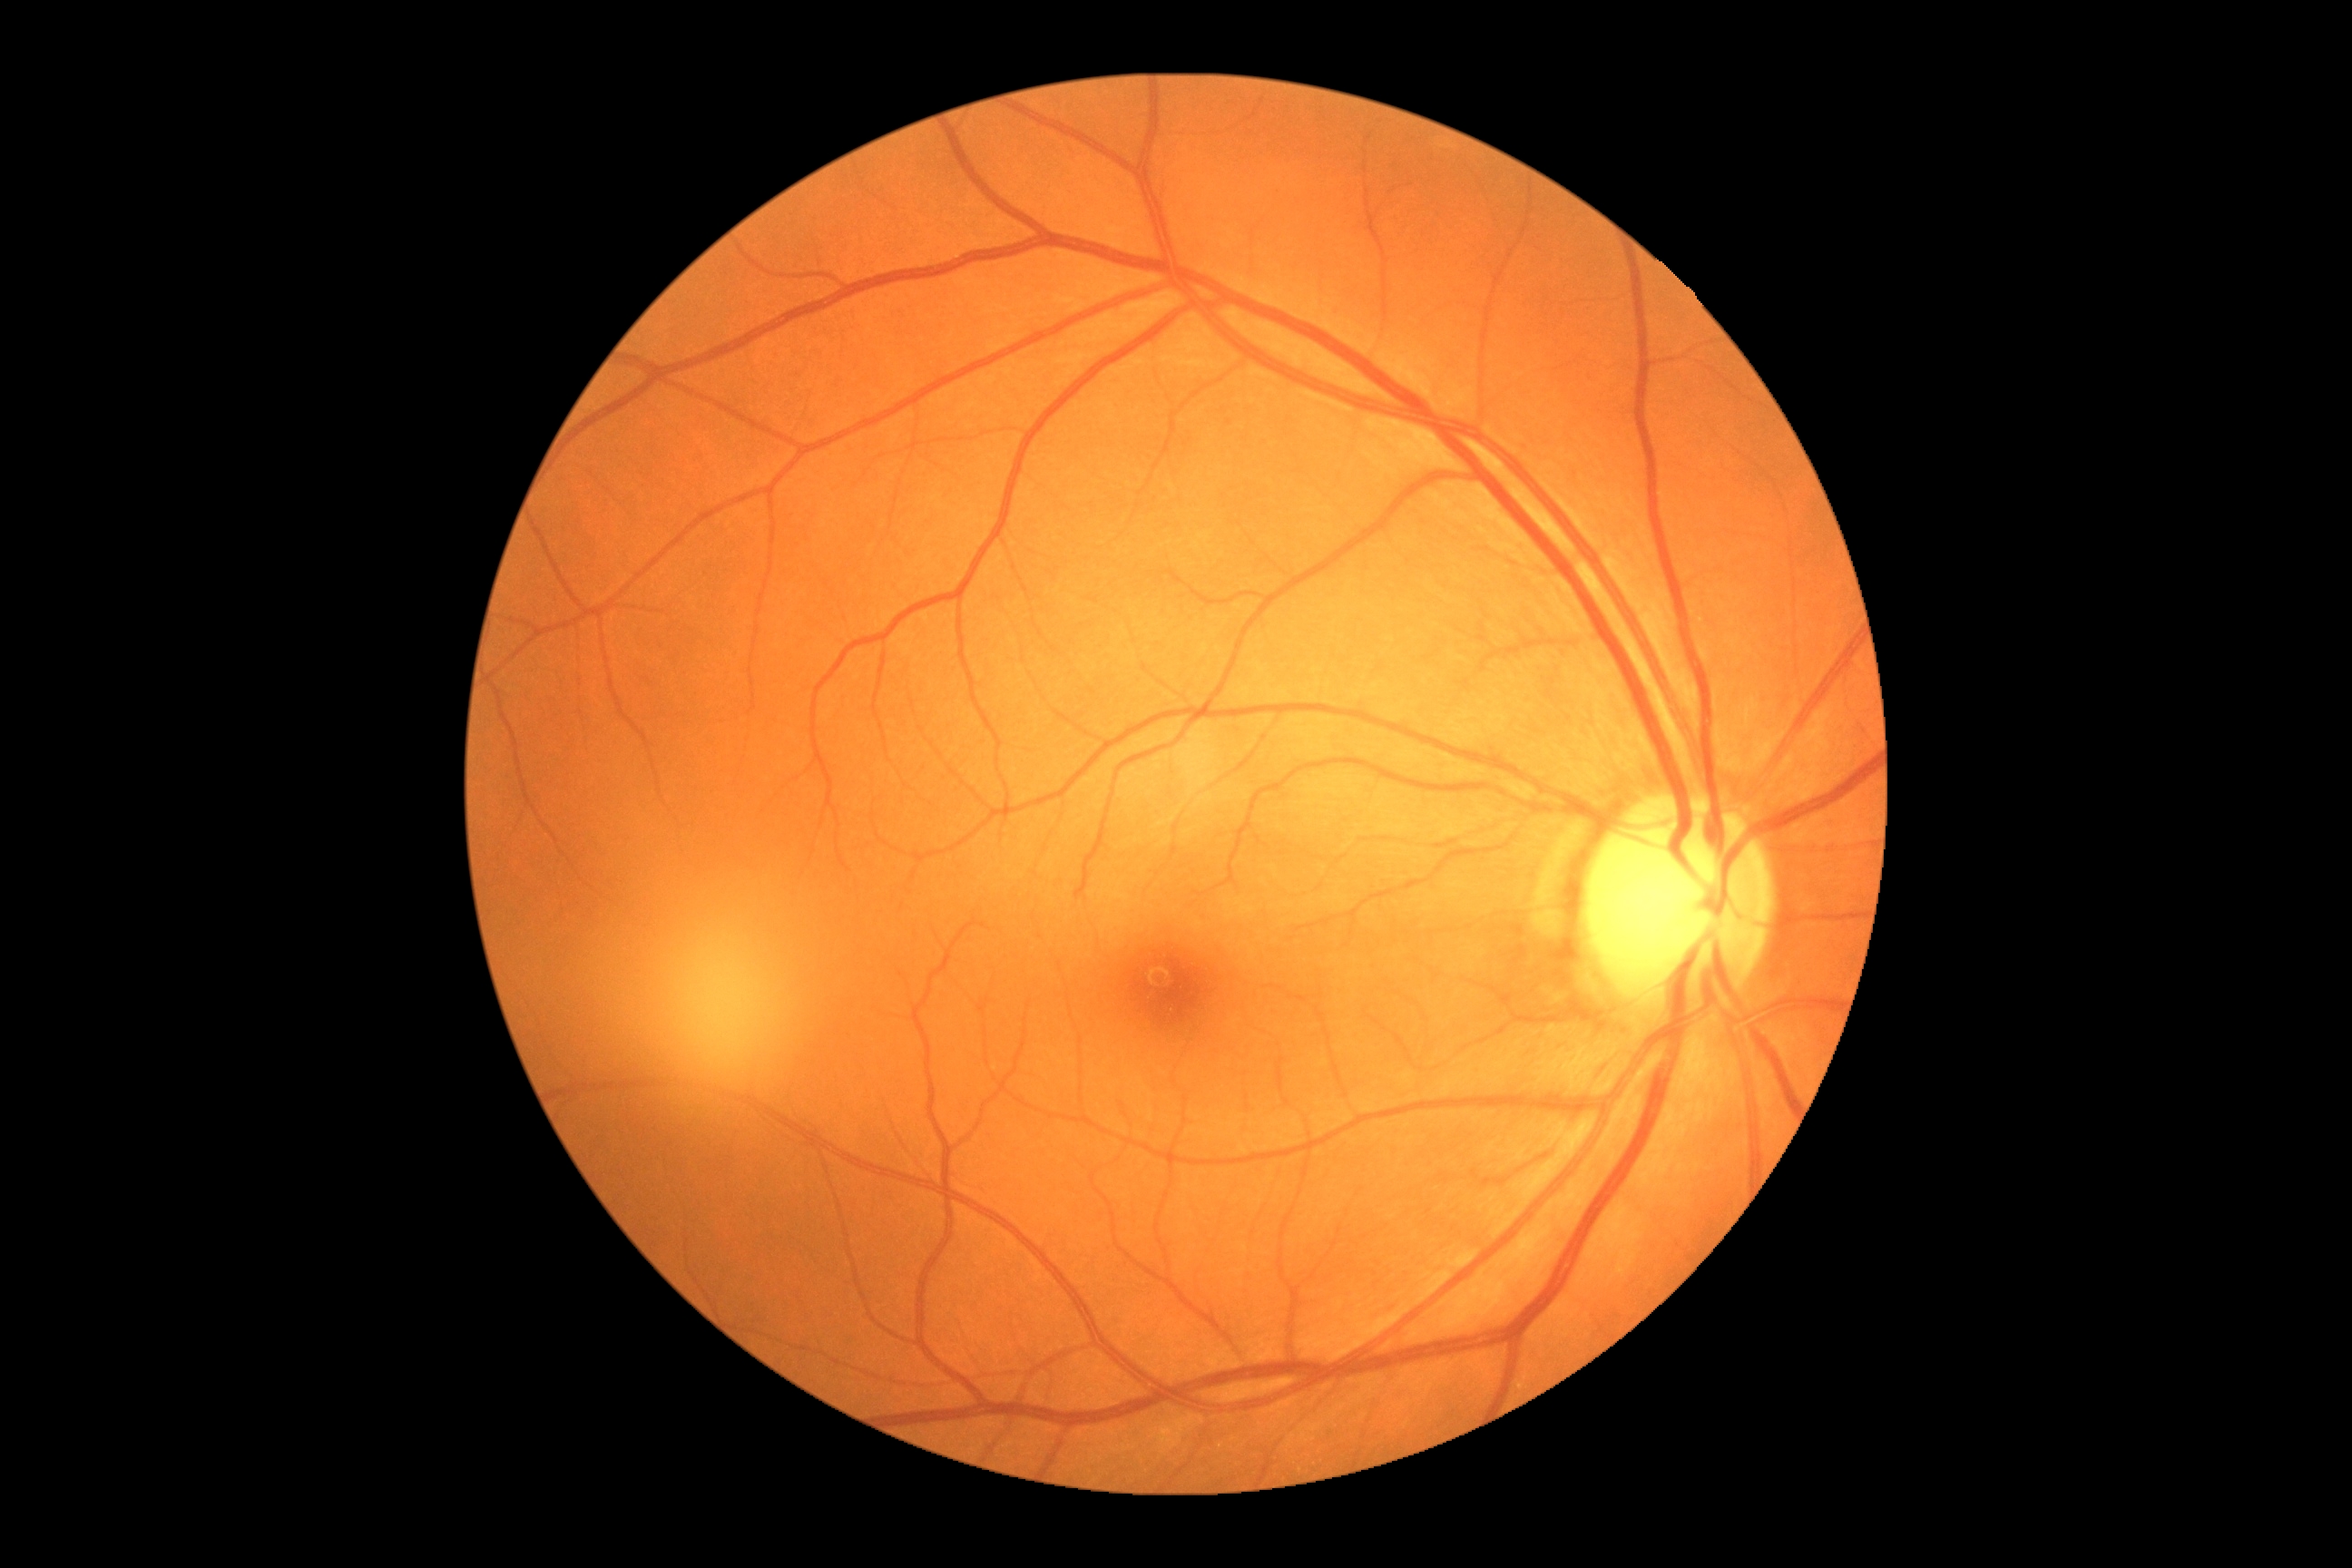
Diabetic retinopathy (DR): grade 0 (no apparent retinopathy).